45 degree fundus photograph, 848x848px.
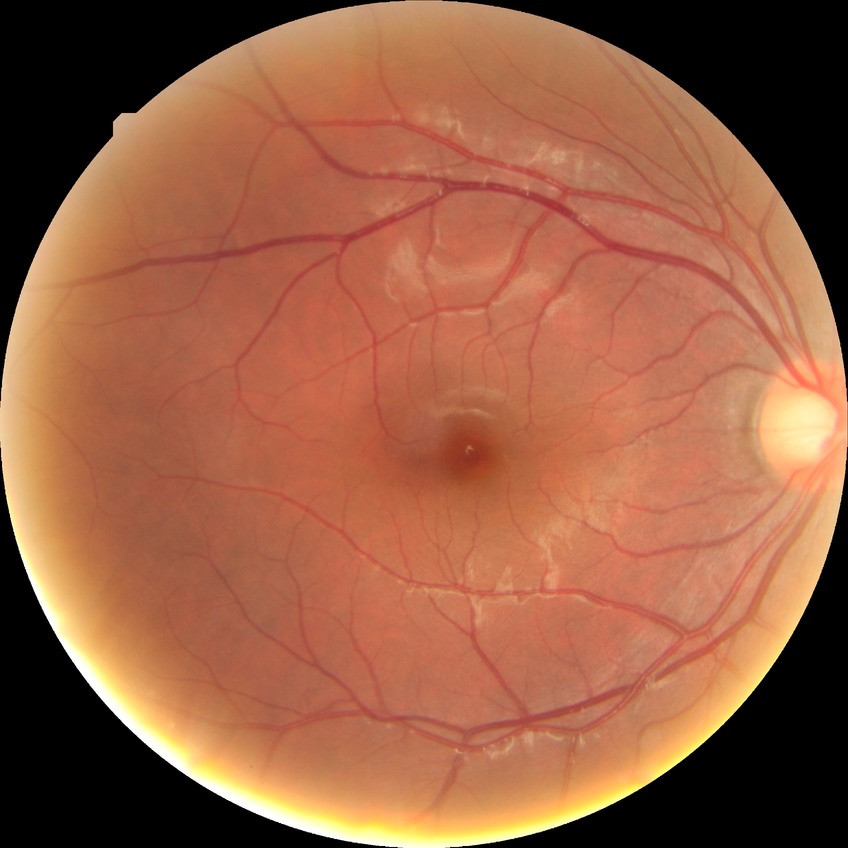
Diabetic retinopathy (DR) is NDR (no diabetic retinopathy).